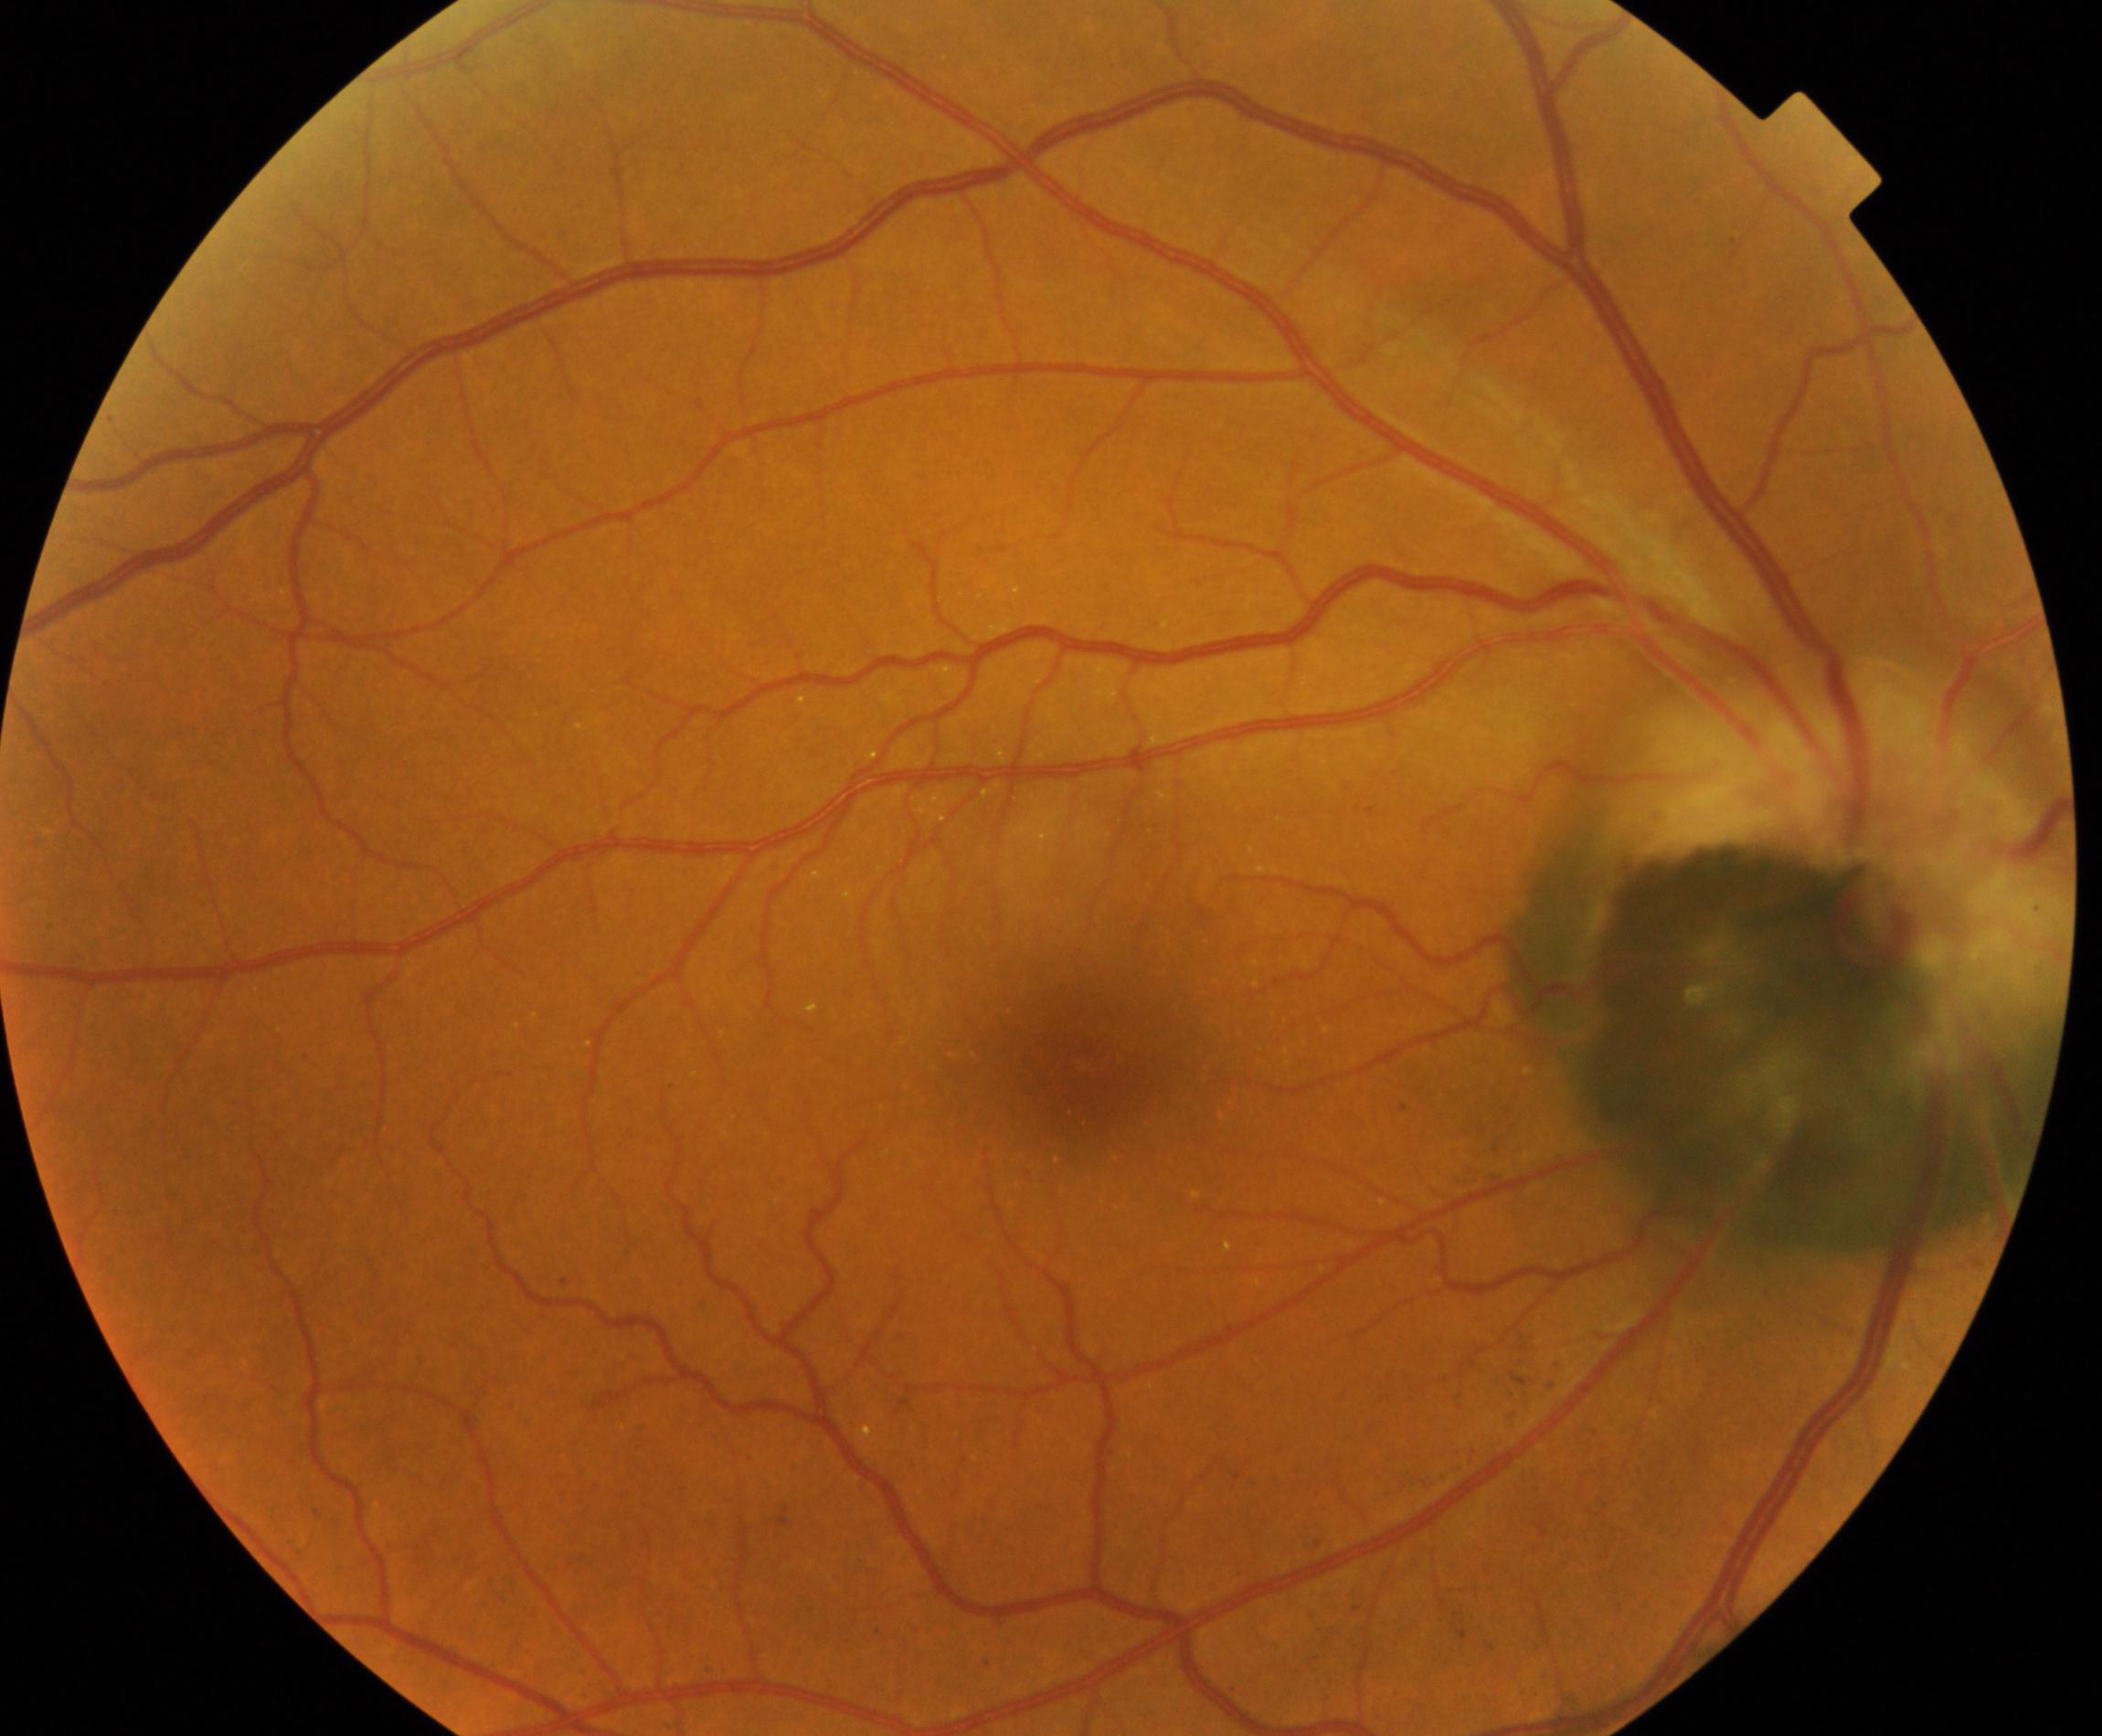
There is evidence of fundus neoplasm.